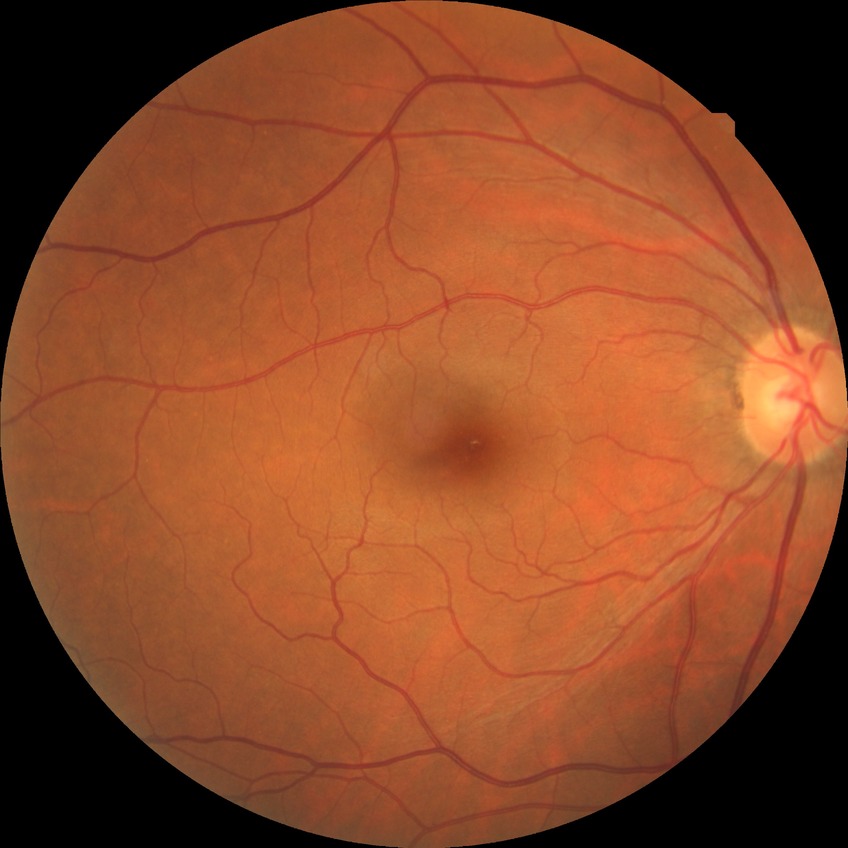 Modified Davis grading: no diabetic retinopathy.